Wide-field contact fundus photograph of an infant. 1240 x 1240 pixels. Acquired on the Phoenix ICON
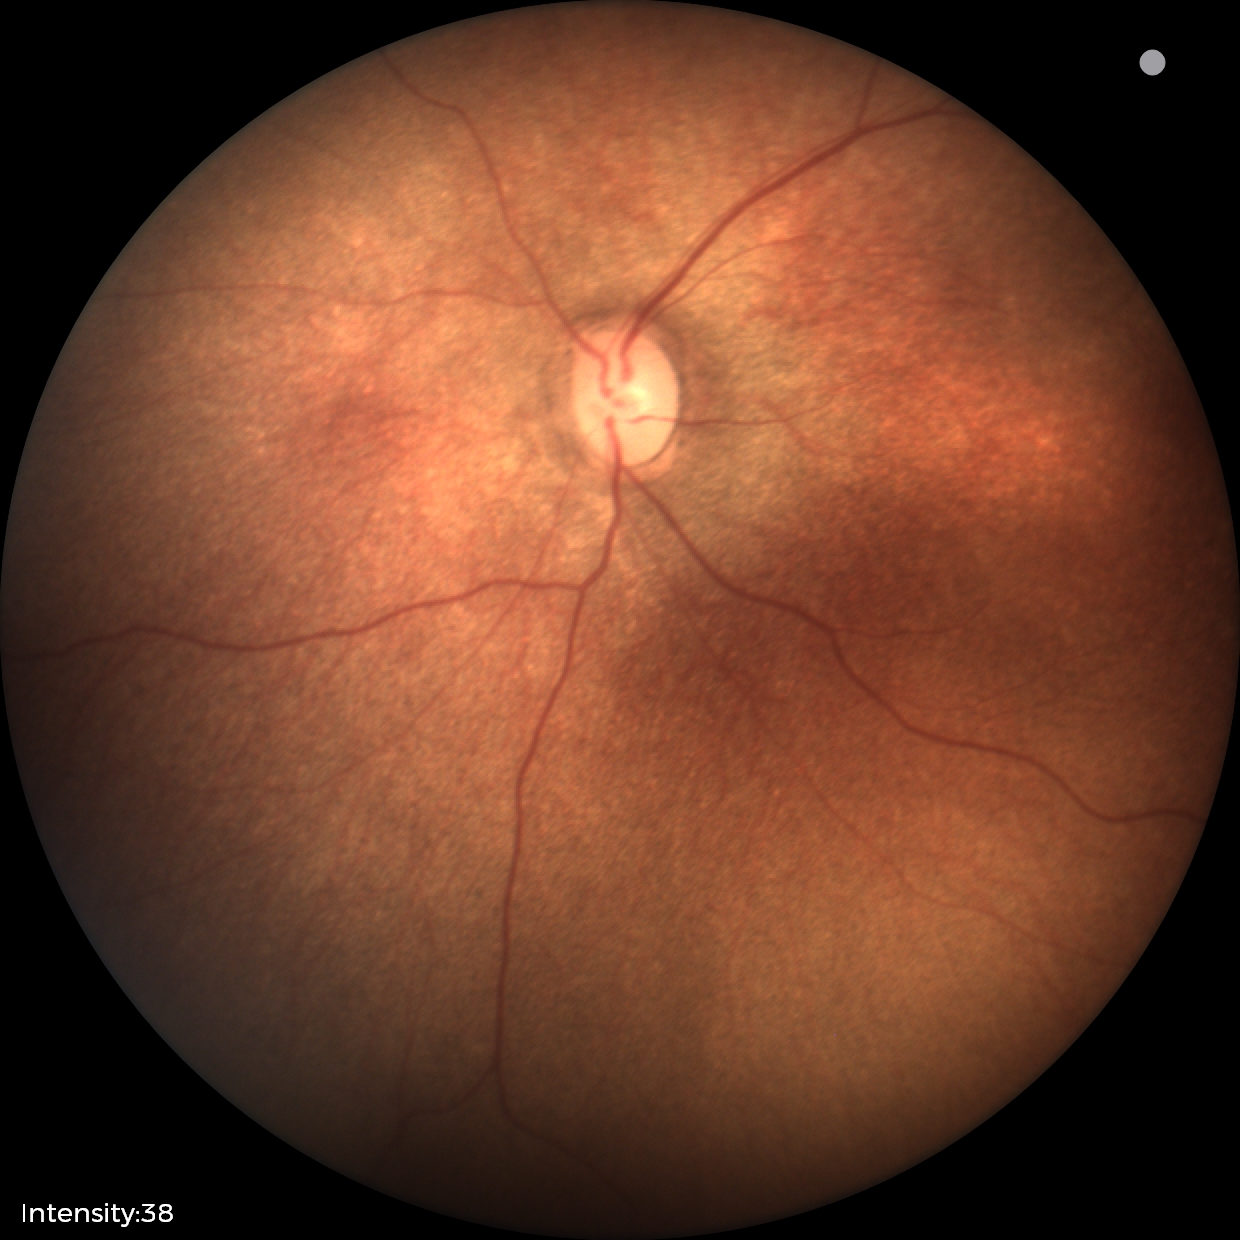 Assessment: physiological appearance with no retinal pathology.